UWF retinal mosaic, 200° field of view, 1924x1556px:
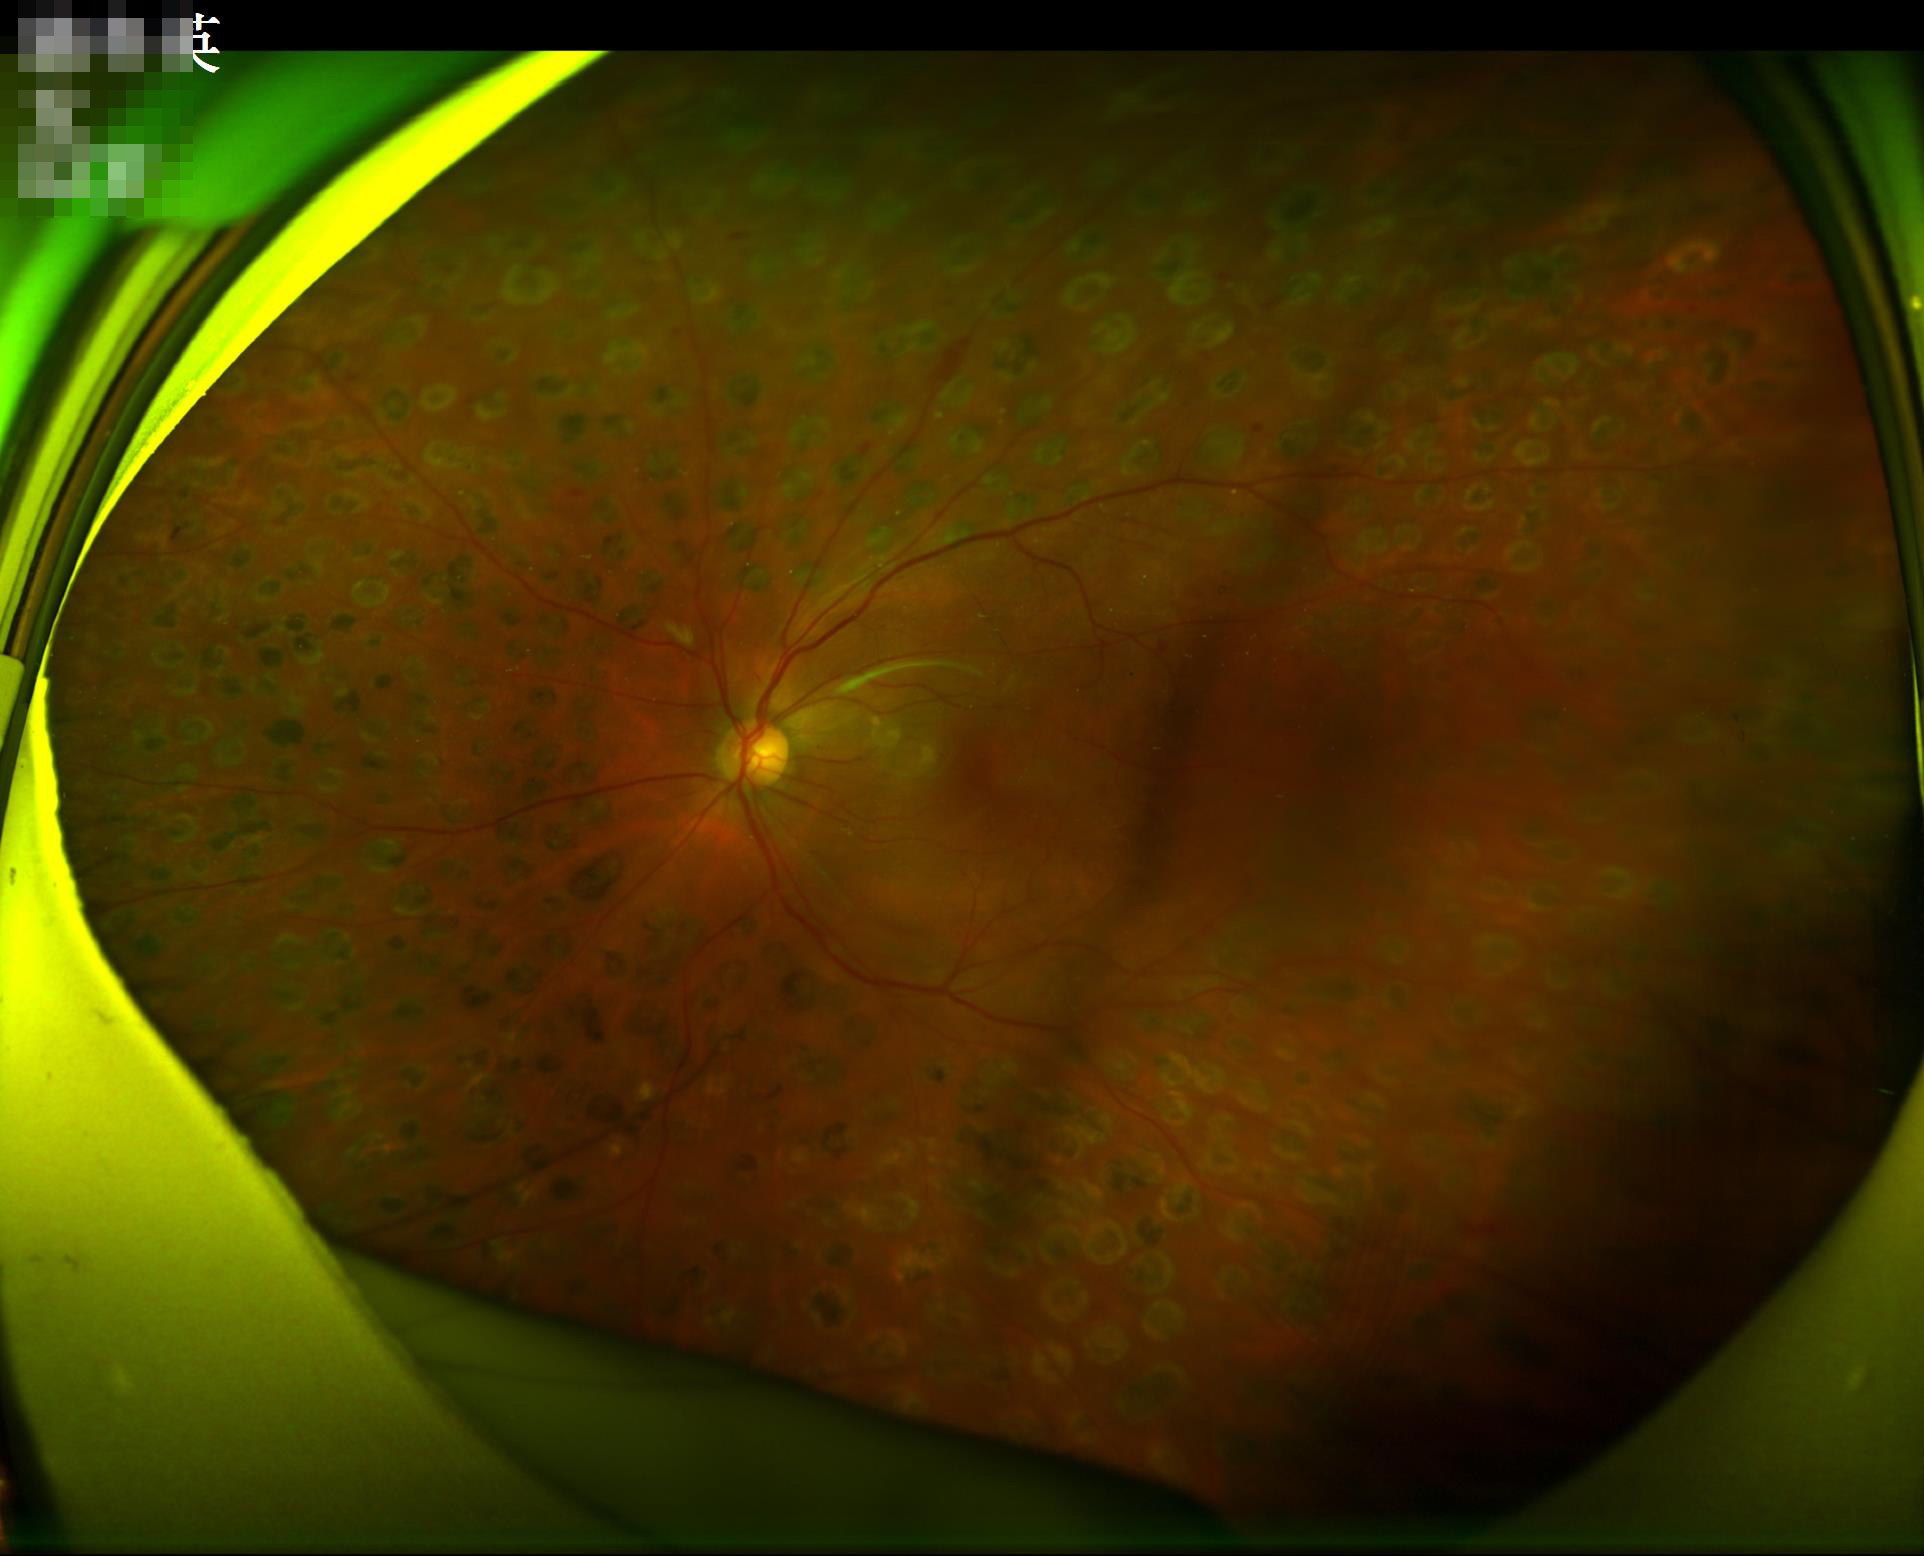 Overall quality is good and the image is gradable. Illumination is even.